50° FOV.
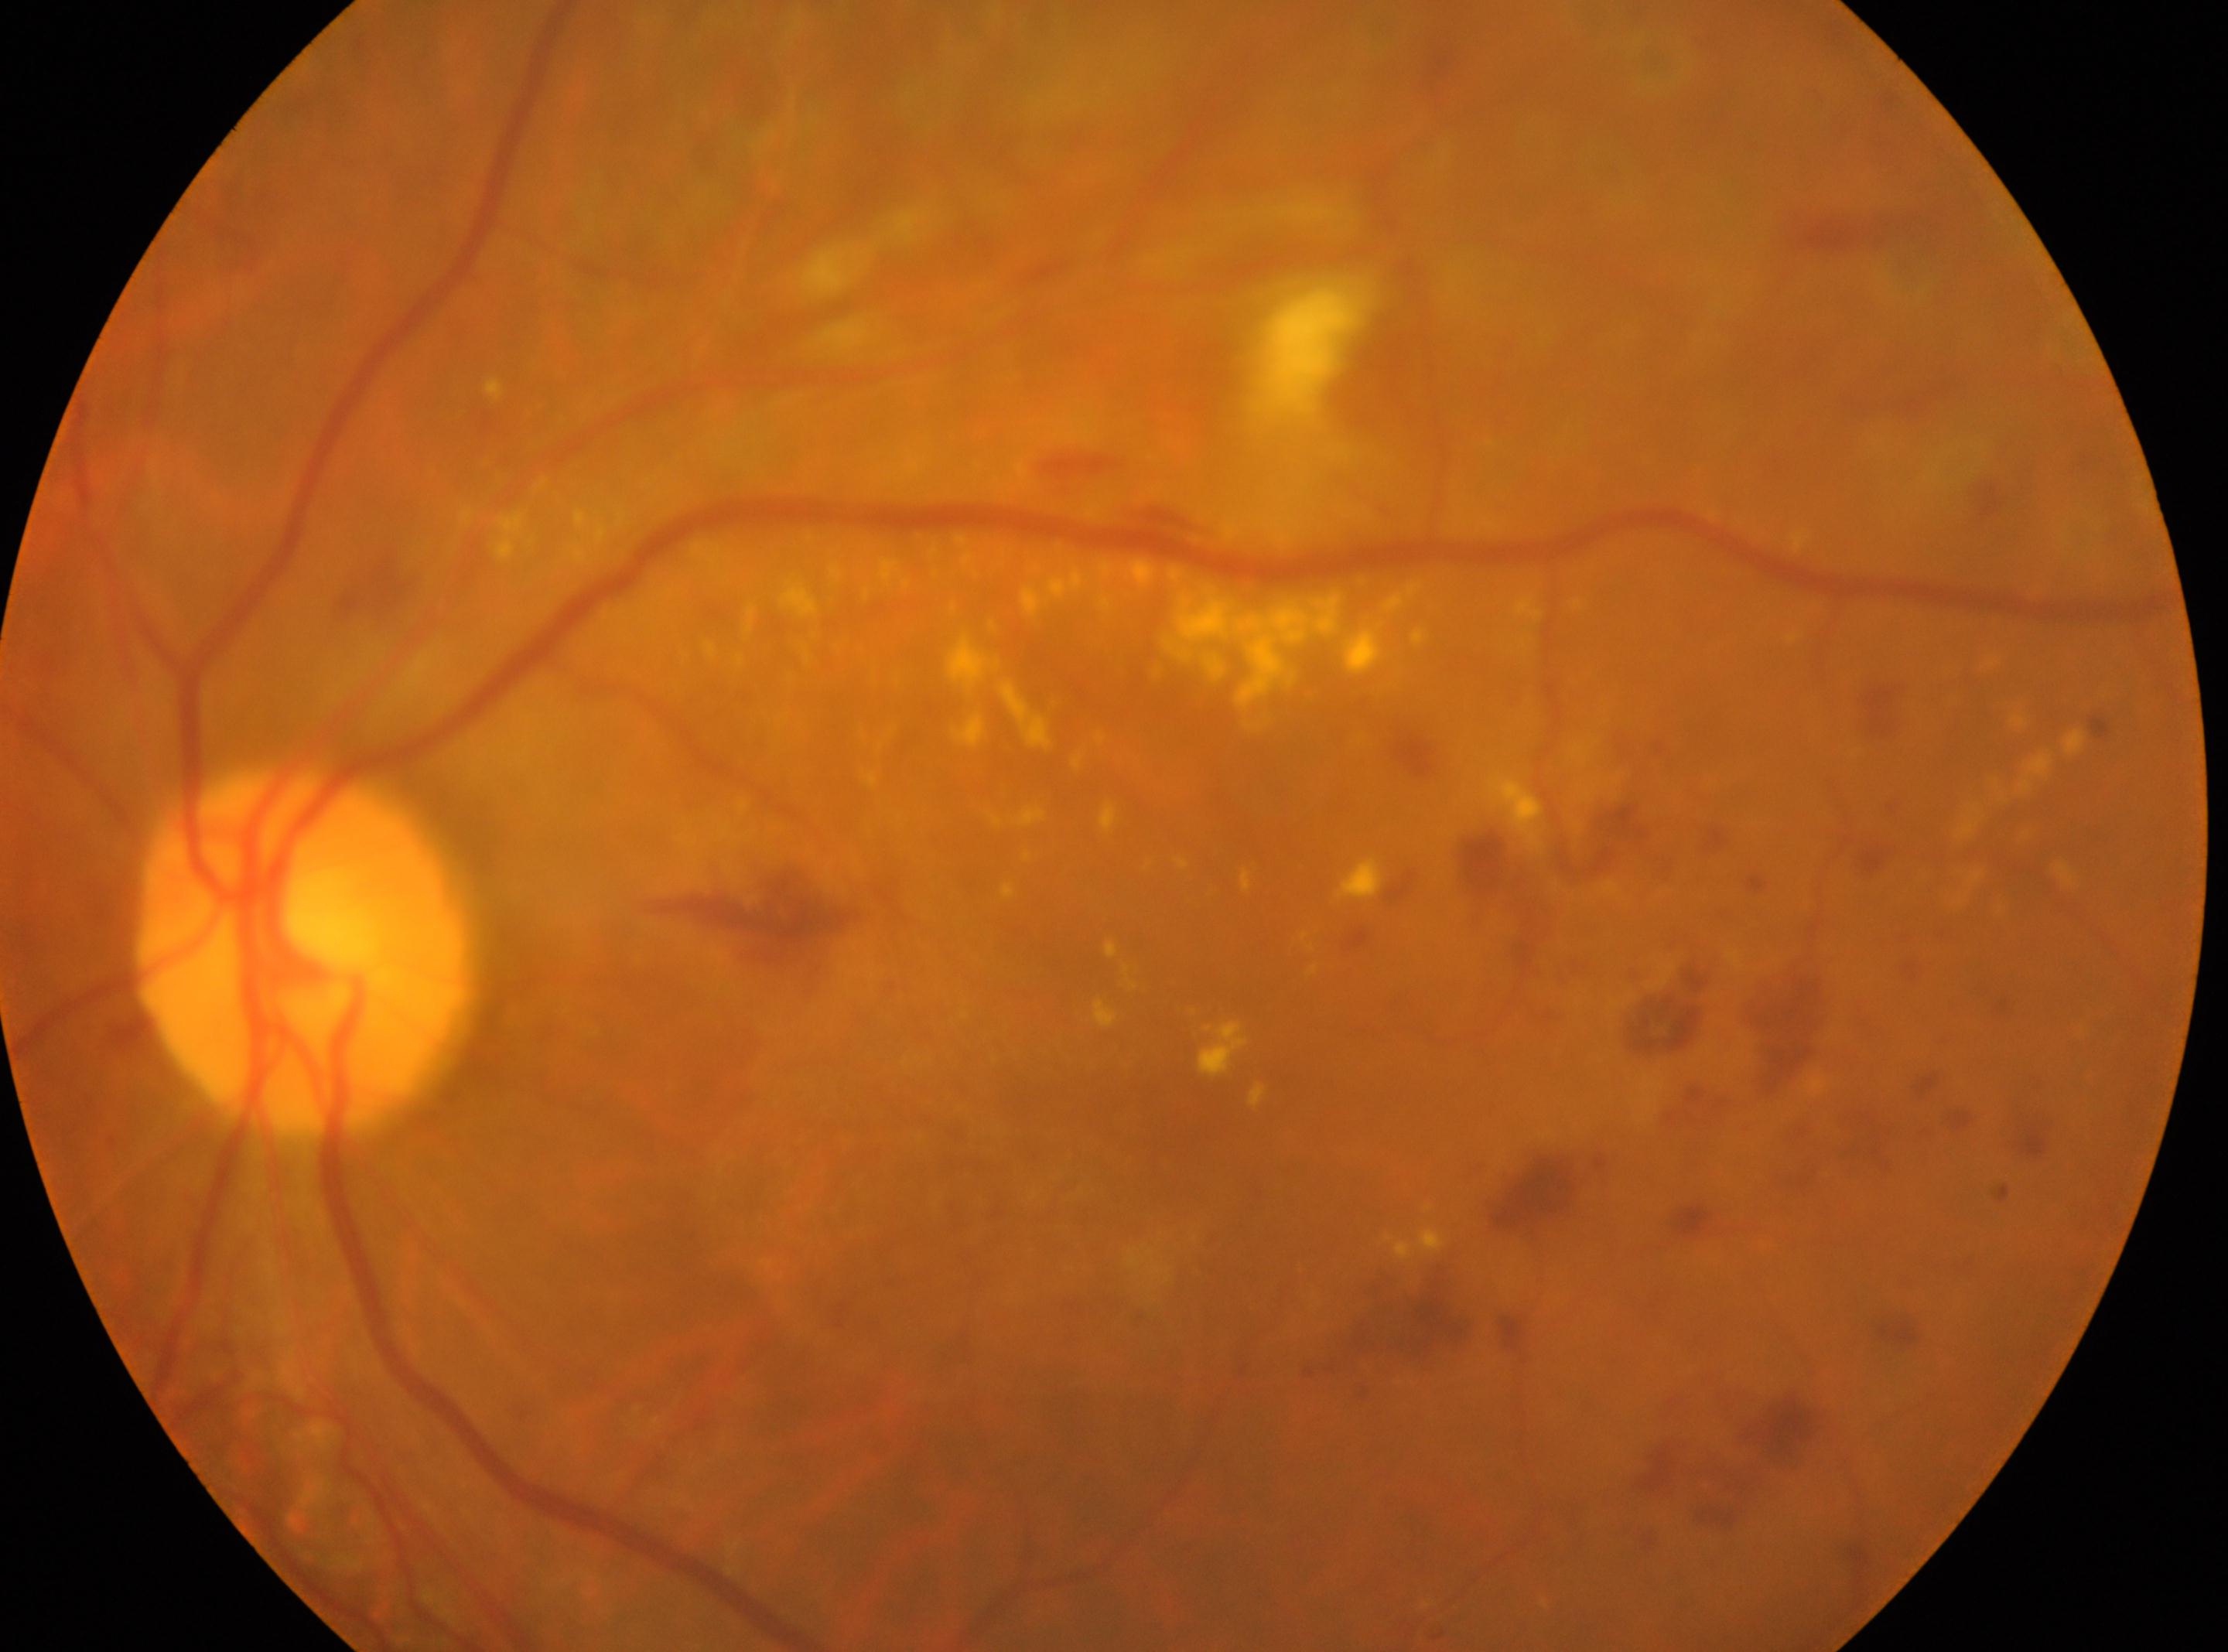 optic disc center=(303, 948)
DR severity=DR with laser photocoagulation scars, with underlying severe non-proliferative diabetic retinopathy (grade 3)
OS
macula center=(1193, 1106)